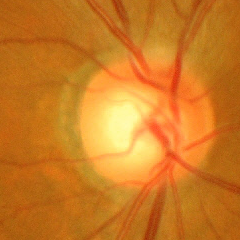

Advanced-stage glaucoma.